Color fundus photograph, 45-degree field of view: 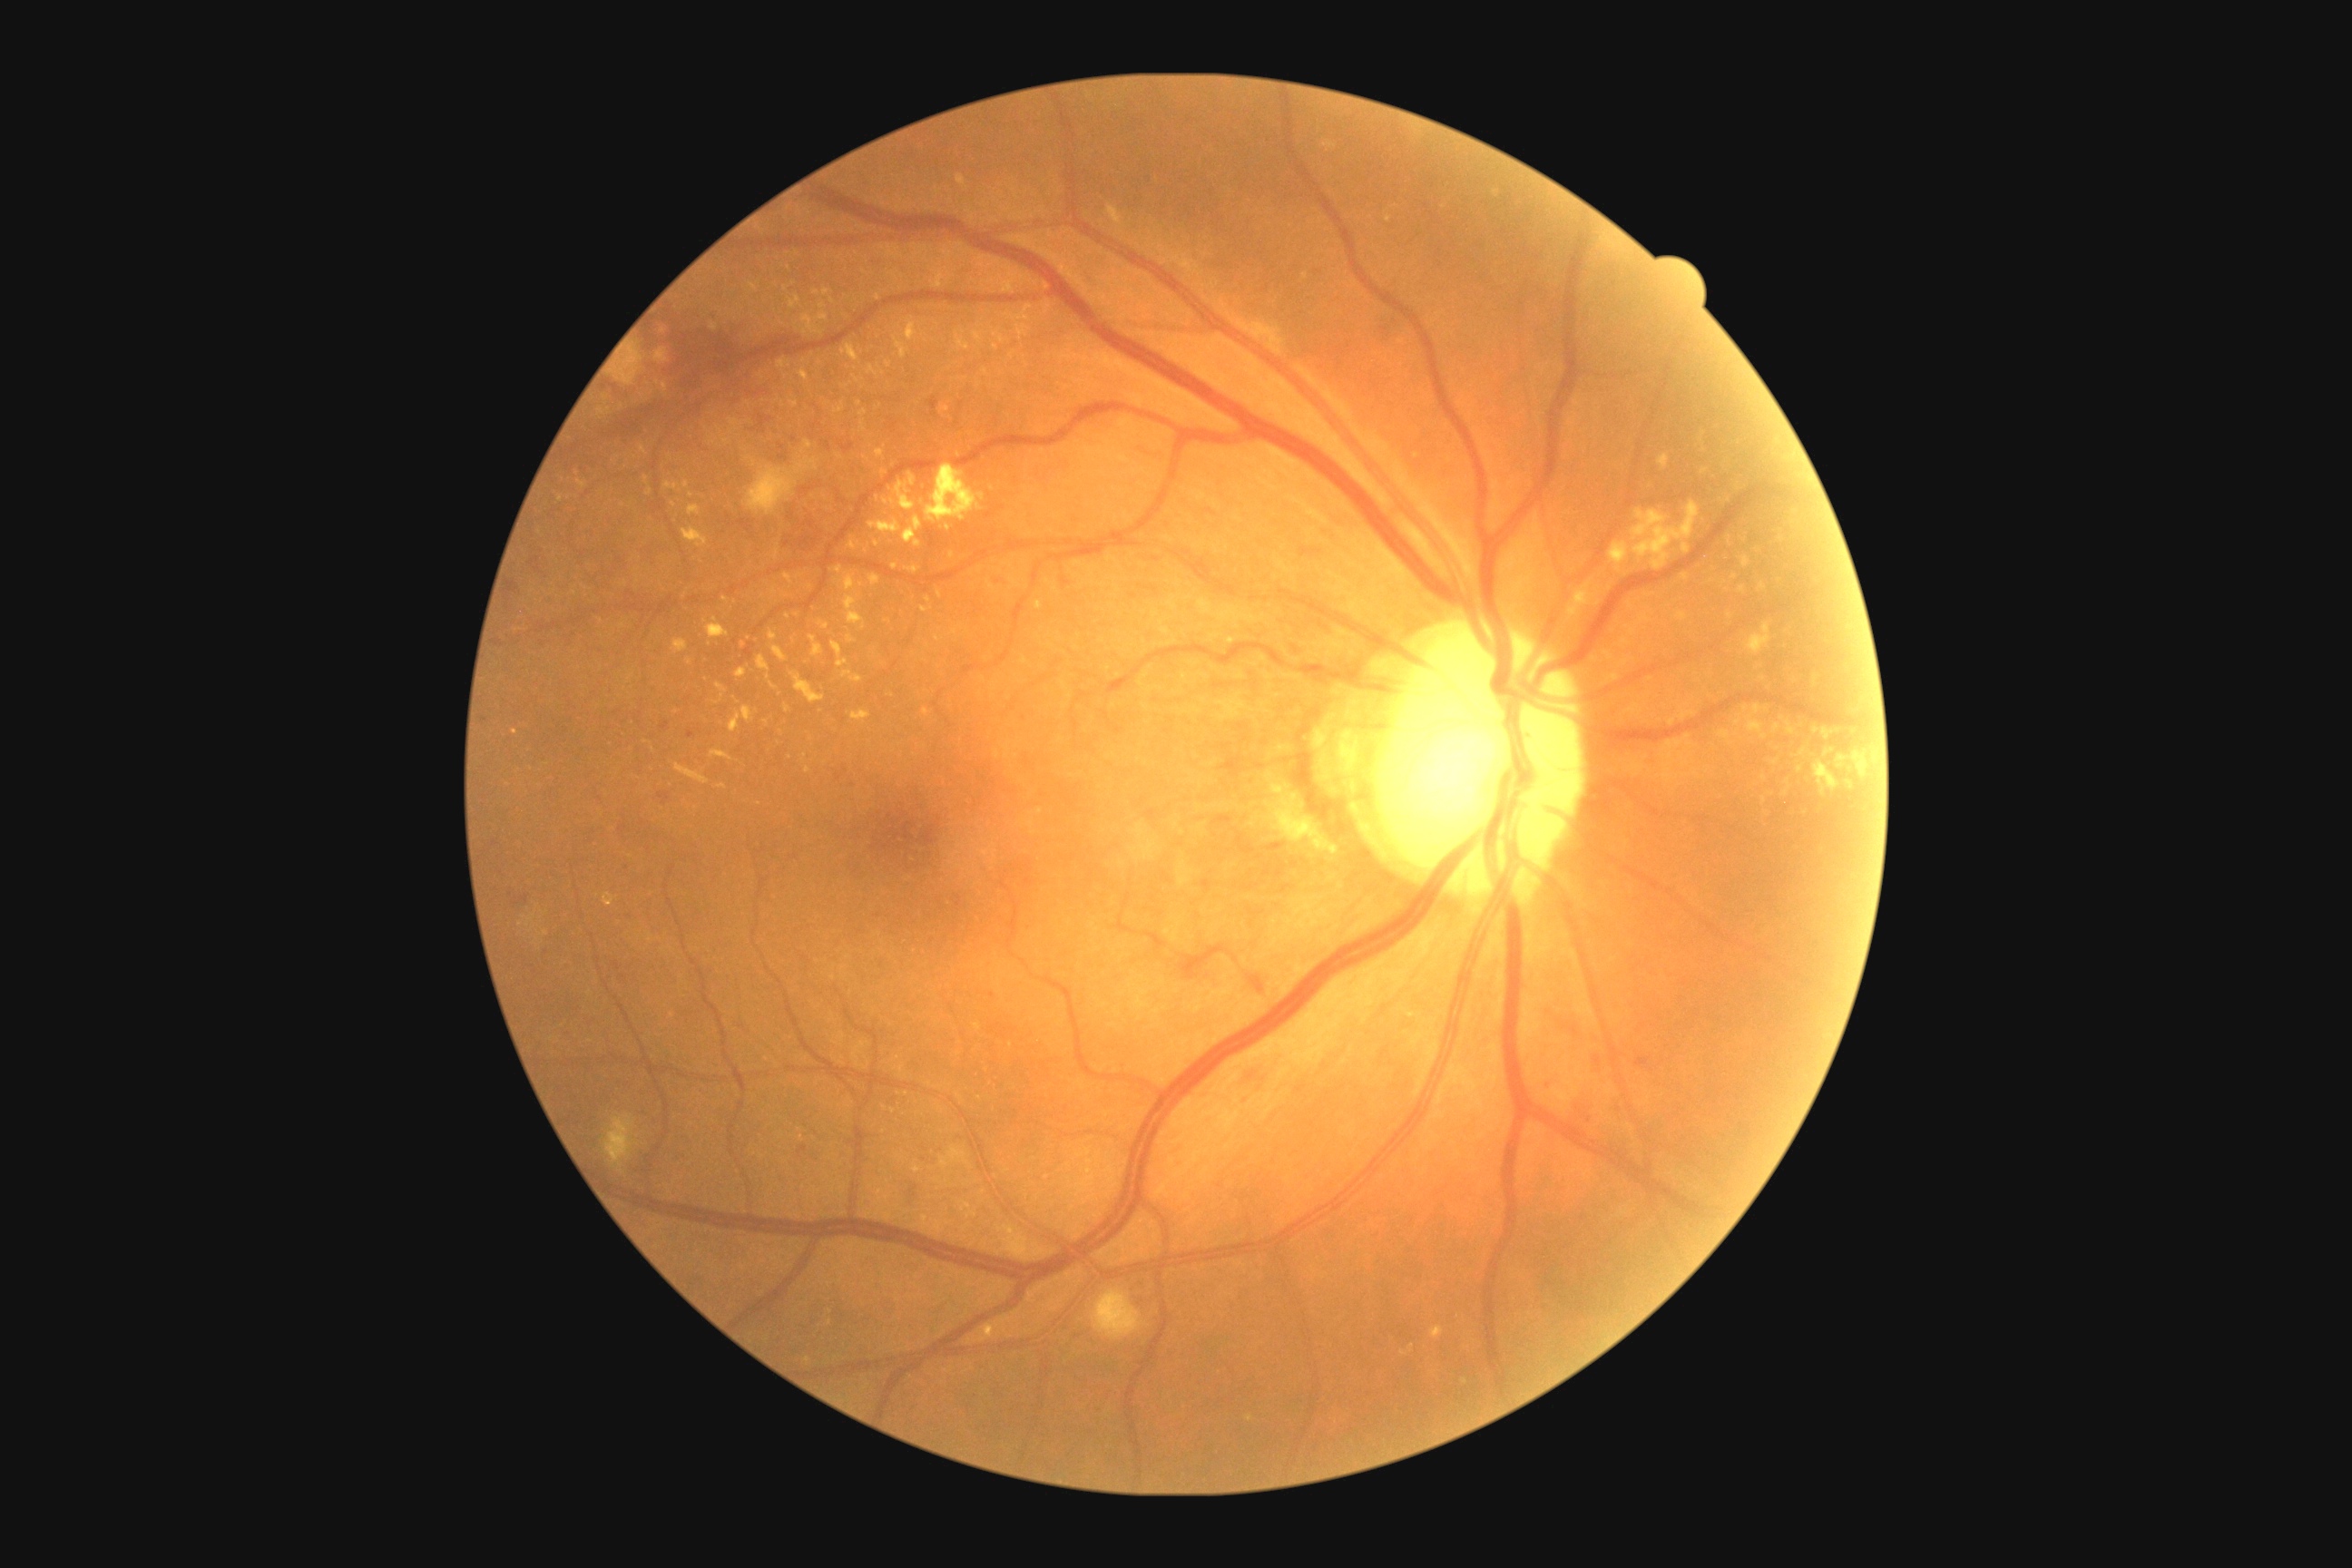

• DR grade: 2/4 — more than just microaneurysms but less than severe NPDR
• DR class: non-proliferative diabetic retinopathy